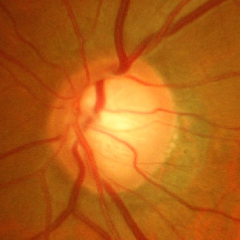 Glaucoma status = advanced glaucomatous optic neuropathy.